1240x1240px. Phoenix ICON wide-field infant fundus image — 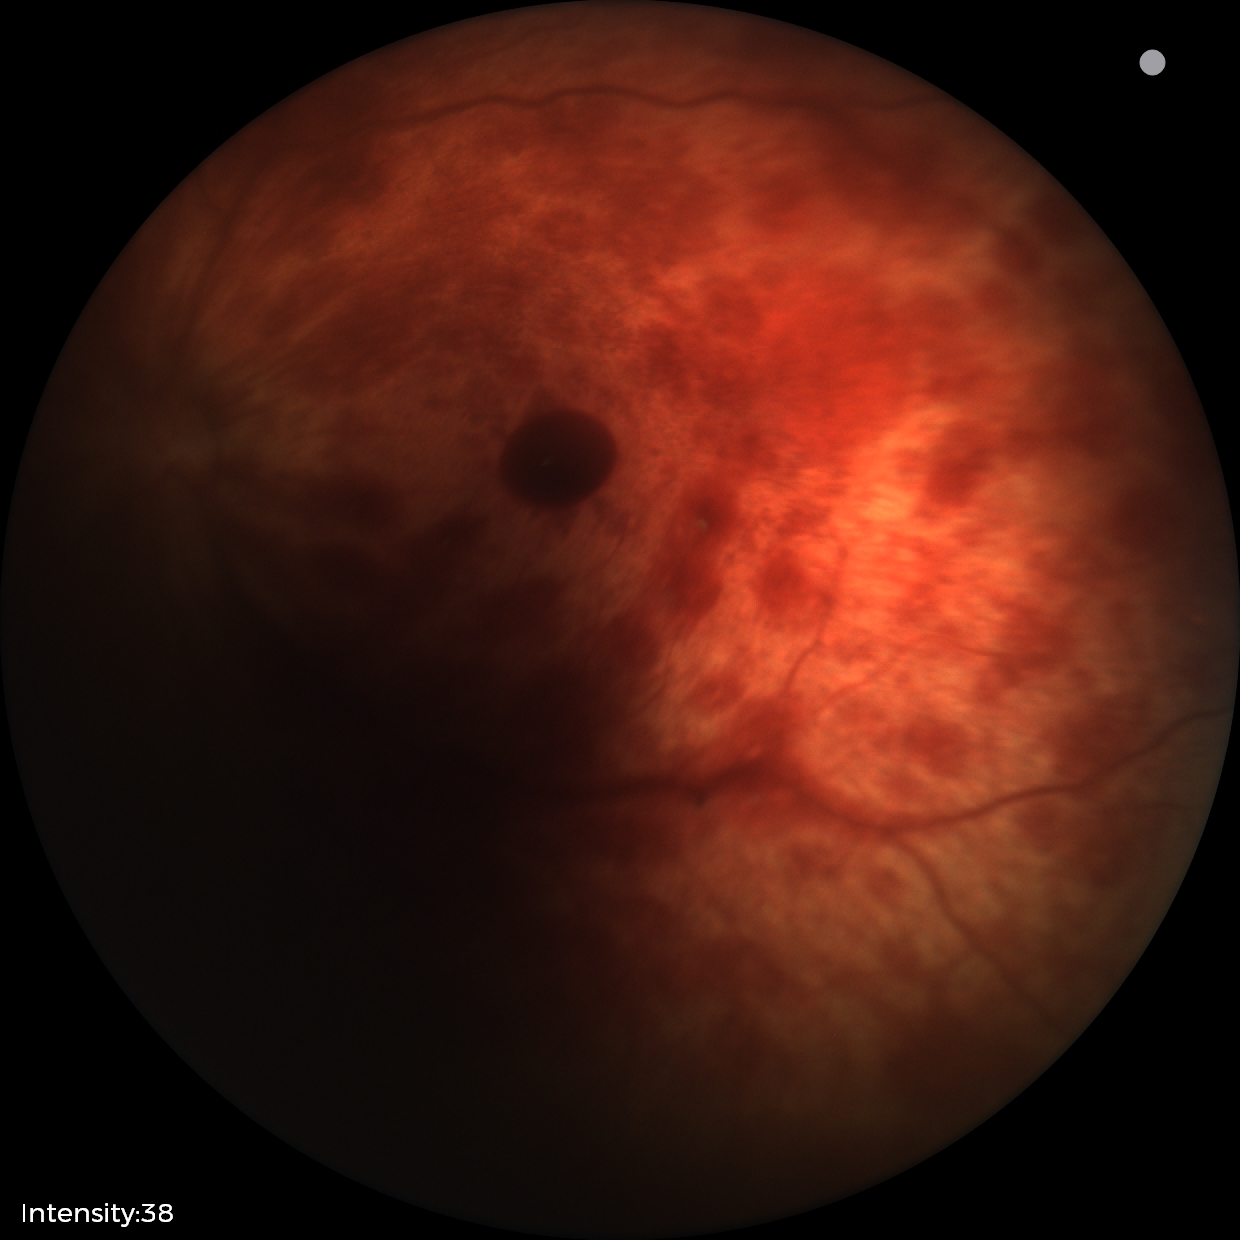 From an examination with diagnosis of retinal hemorrhages.